45° FOV, color fundus image
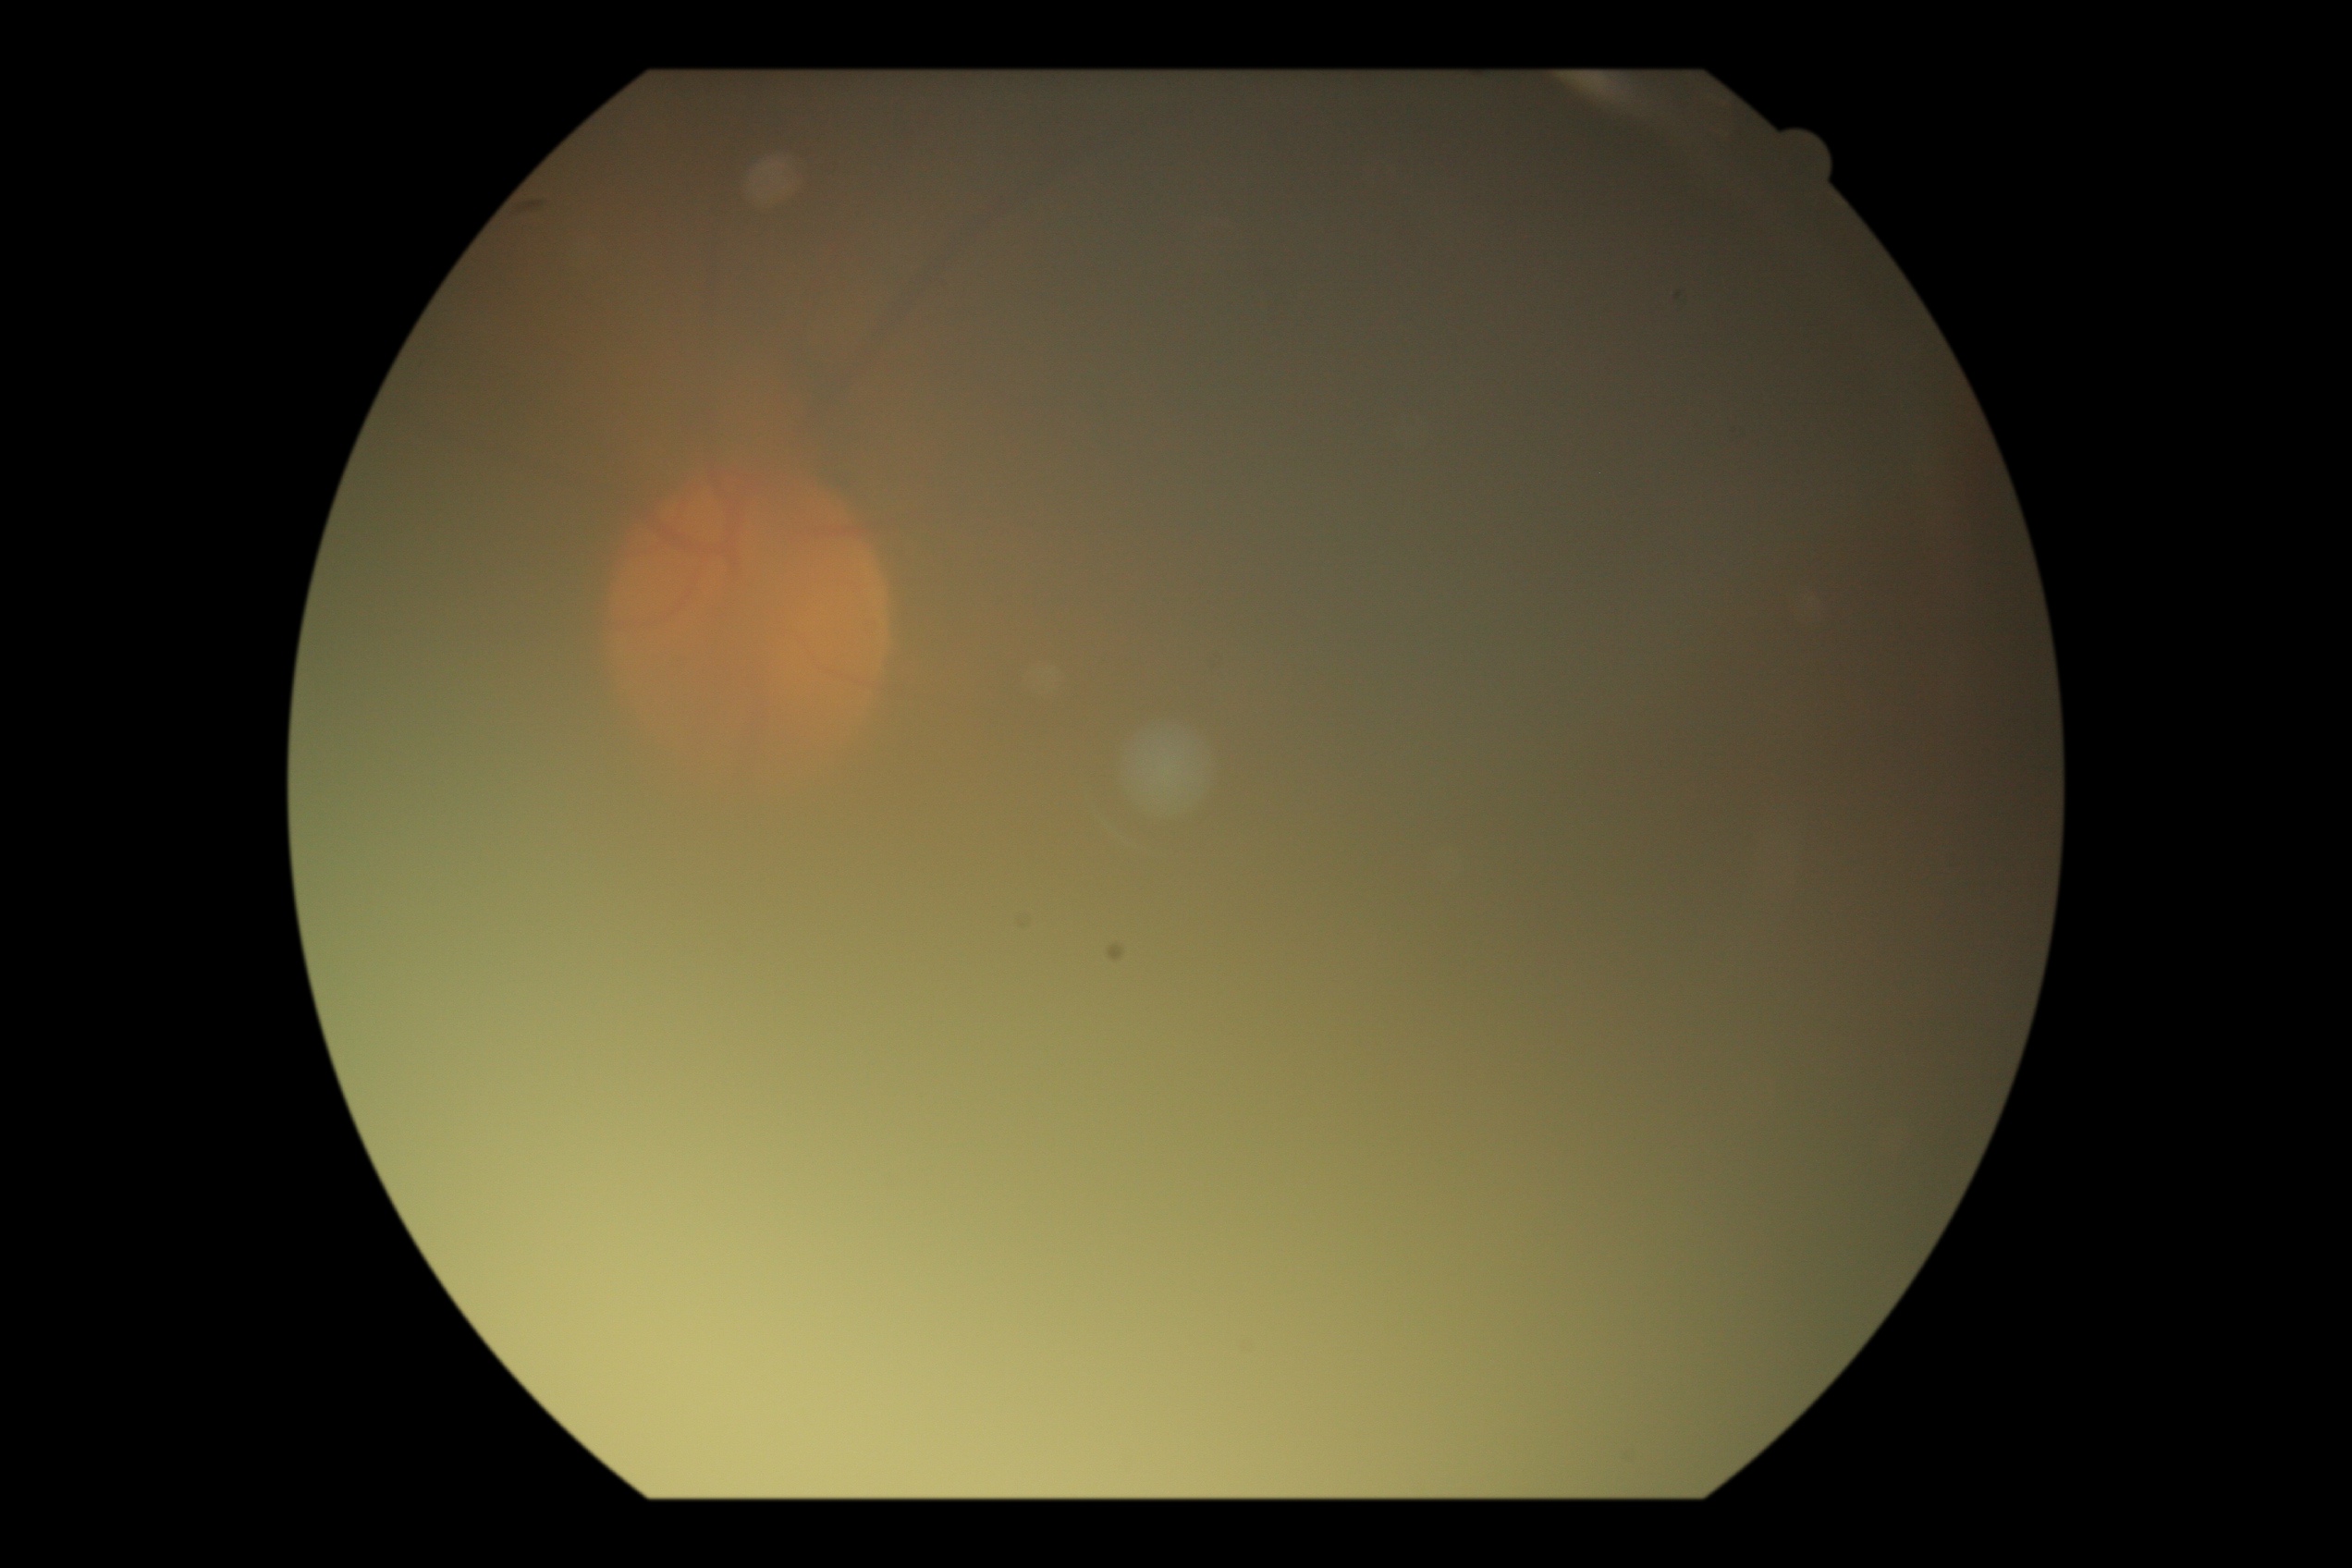
Findings:
– DR stage: ungradable